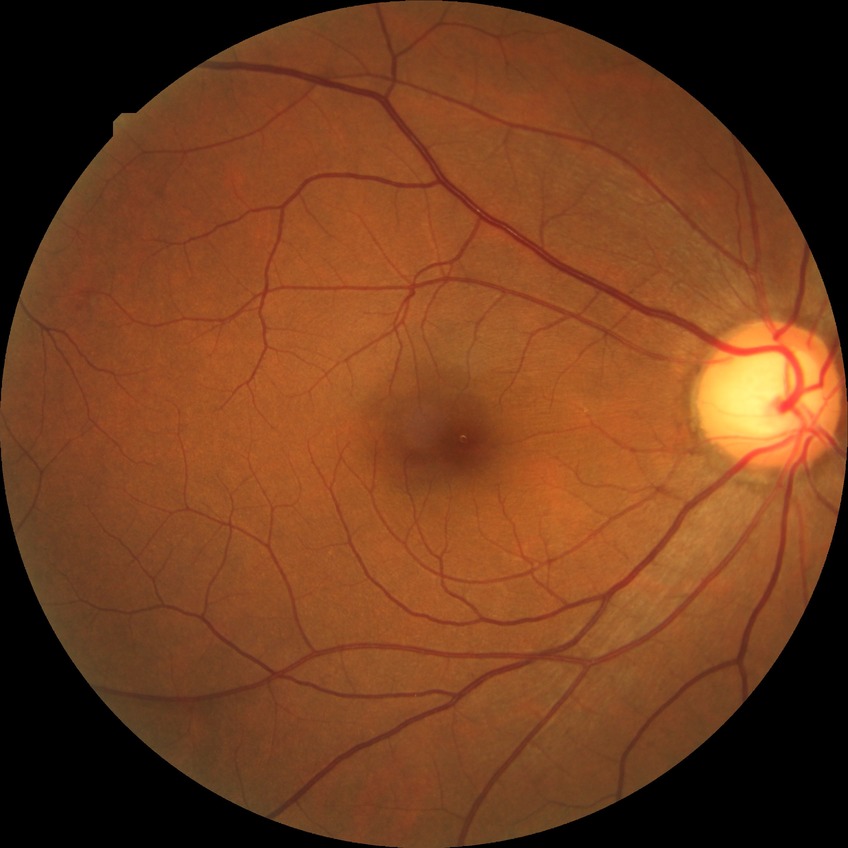
Diabetic retinopathy (DR) is no diabetic retinopathy (NDR).